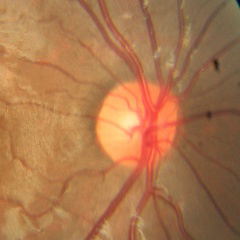

No signs of glaucoma.